2352 x 1568 pixels; color fundus image; 45-degree field of view
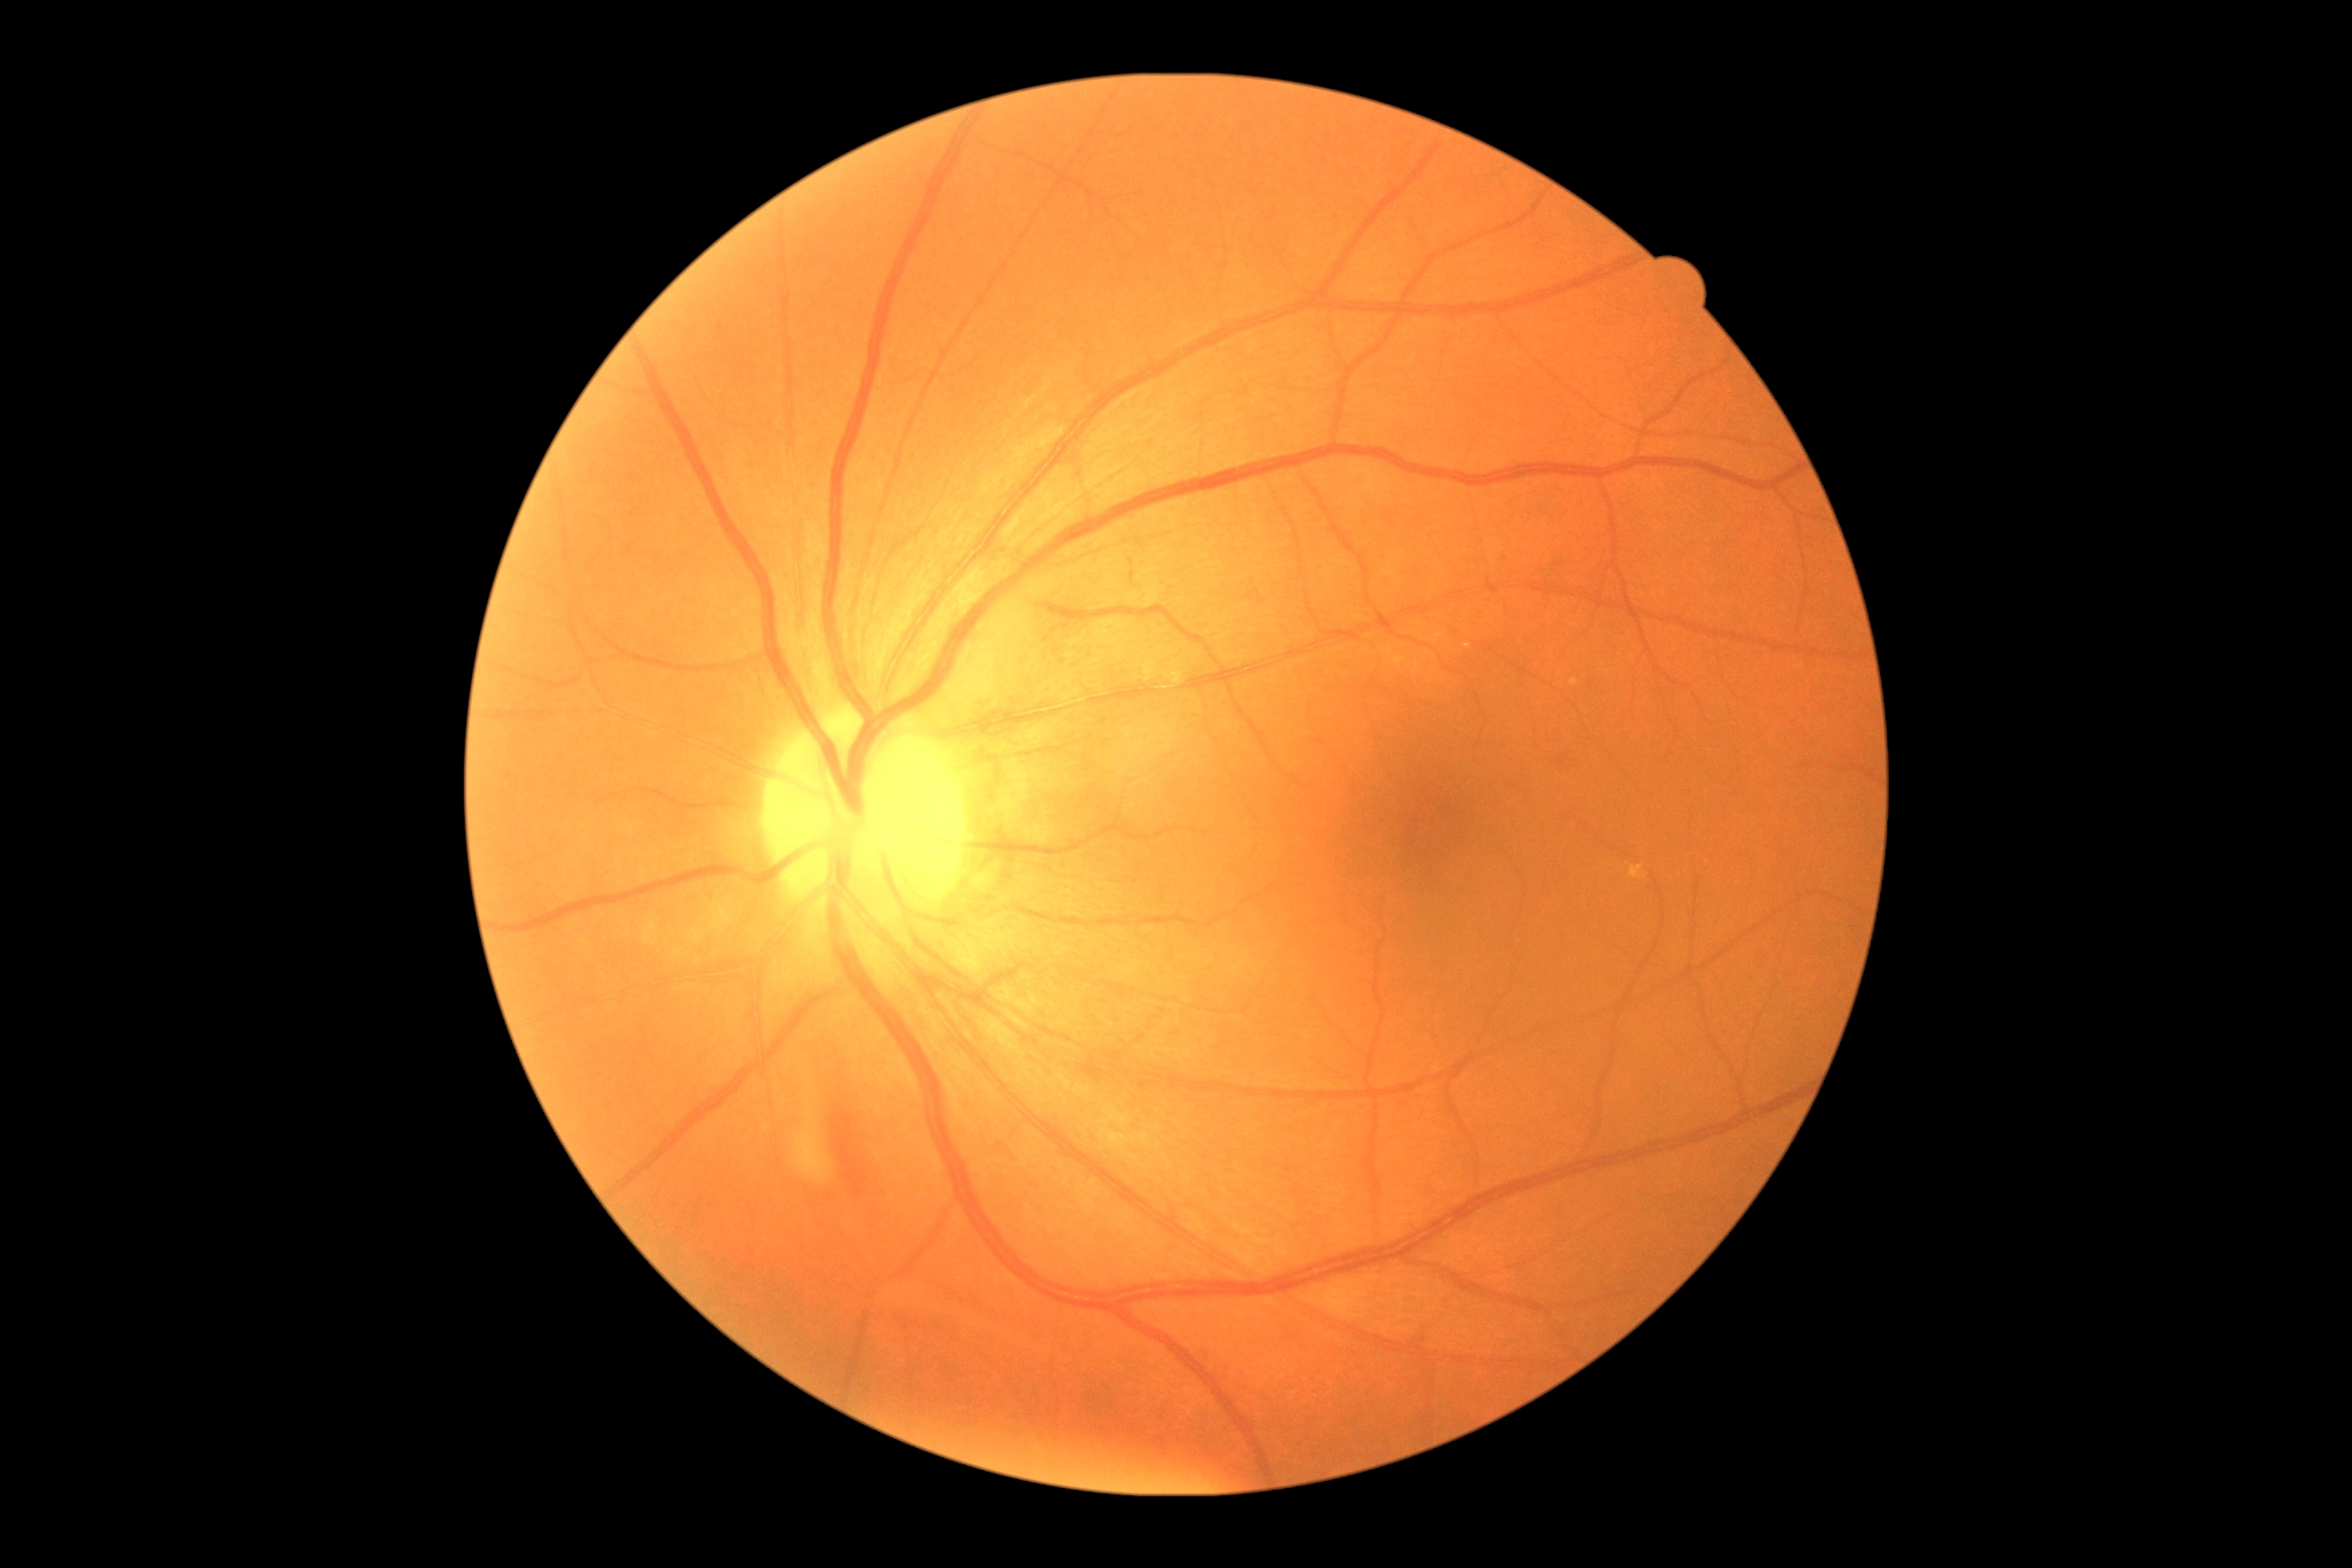

* DR stage: grade 0 (no apparent retinopathy) — no visible signs of diabetic retinopathy